Retinal fundus photograph.
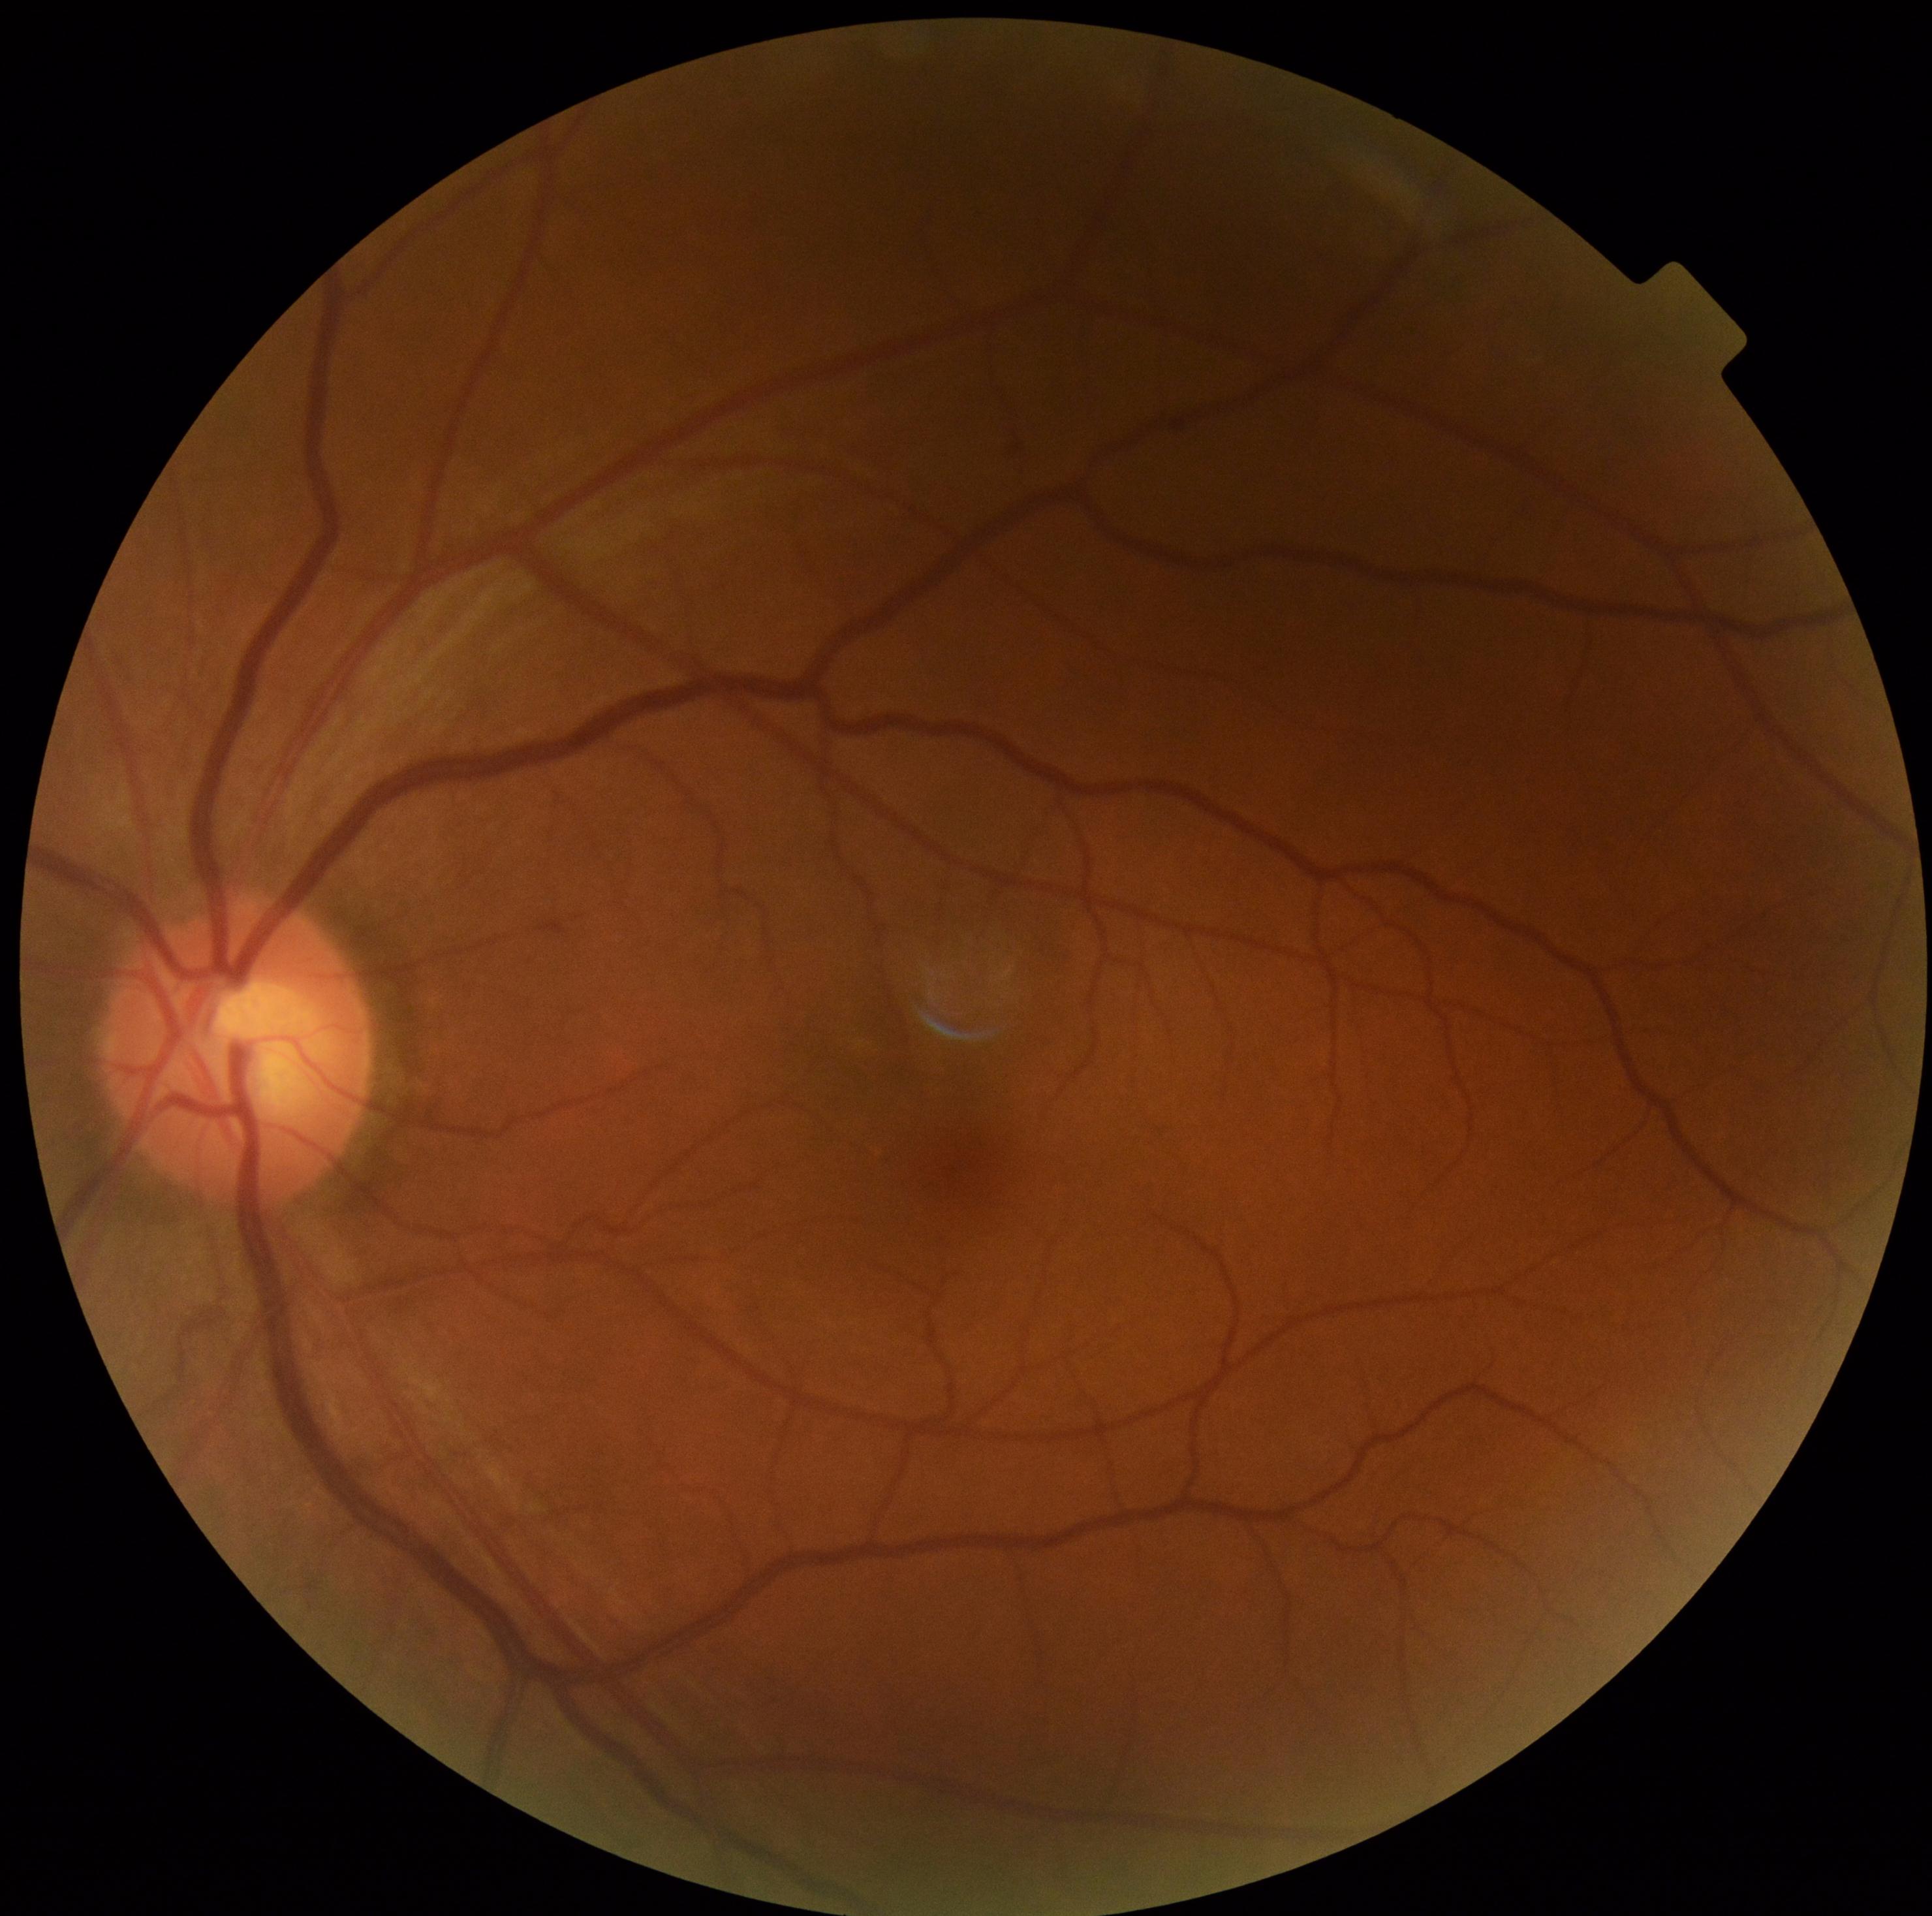

DR@0/4.